Optic disc region of a color fundus photo
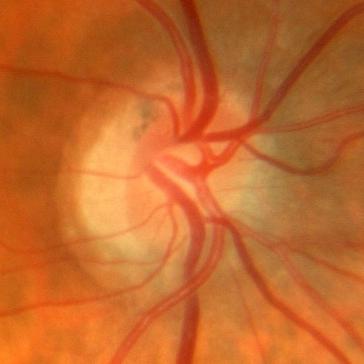 Glaucoma assessment = no glaucomatous optic neuropathy.